45° field of view · color fundus image · image size 848x848 · NIDEK AFC-230 — 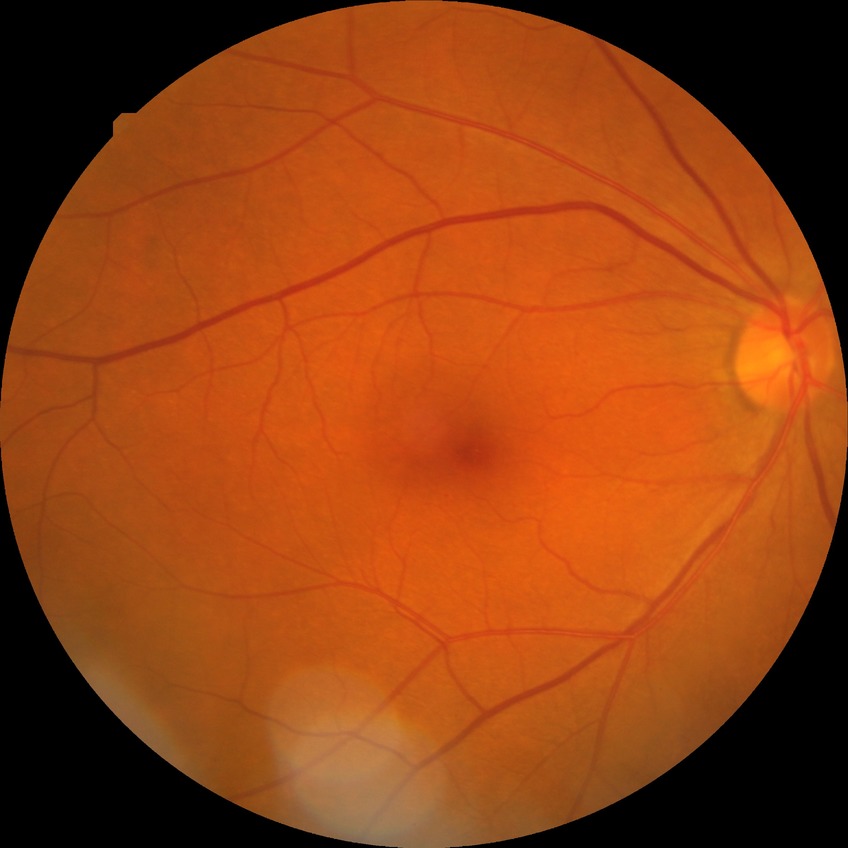
Diabetic retinopathy (DR) is SDR (simple diabetic retinopathy).